Acquired with a Bosch handheld fundus camera:
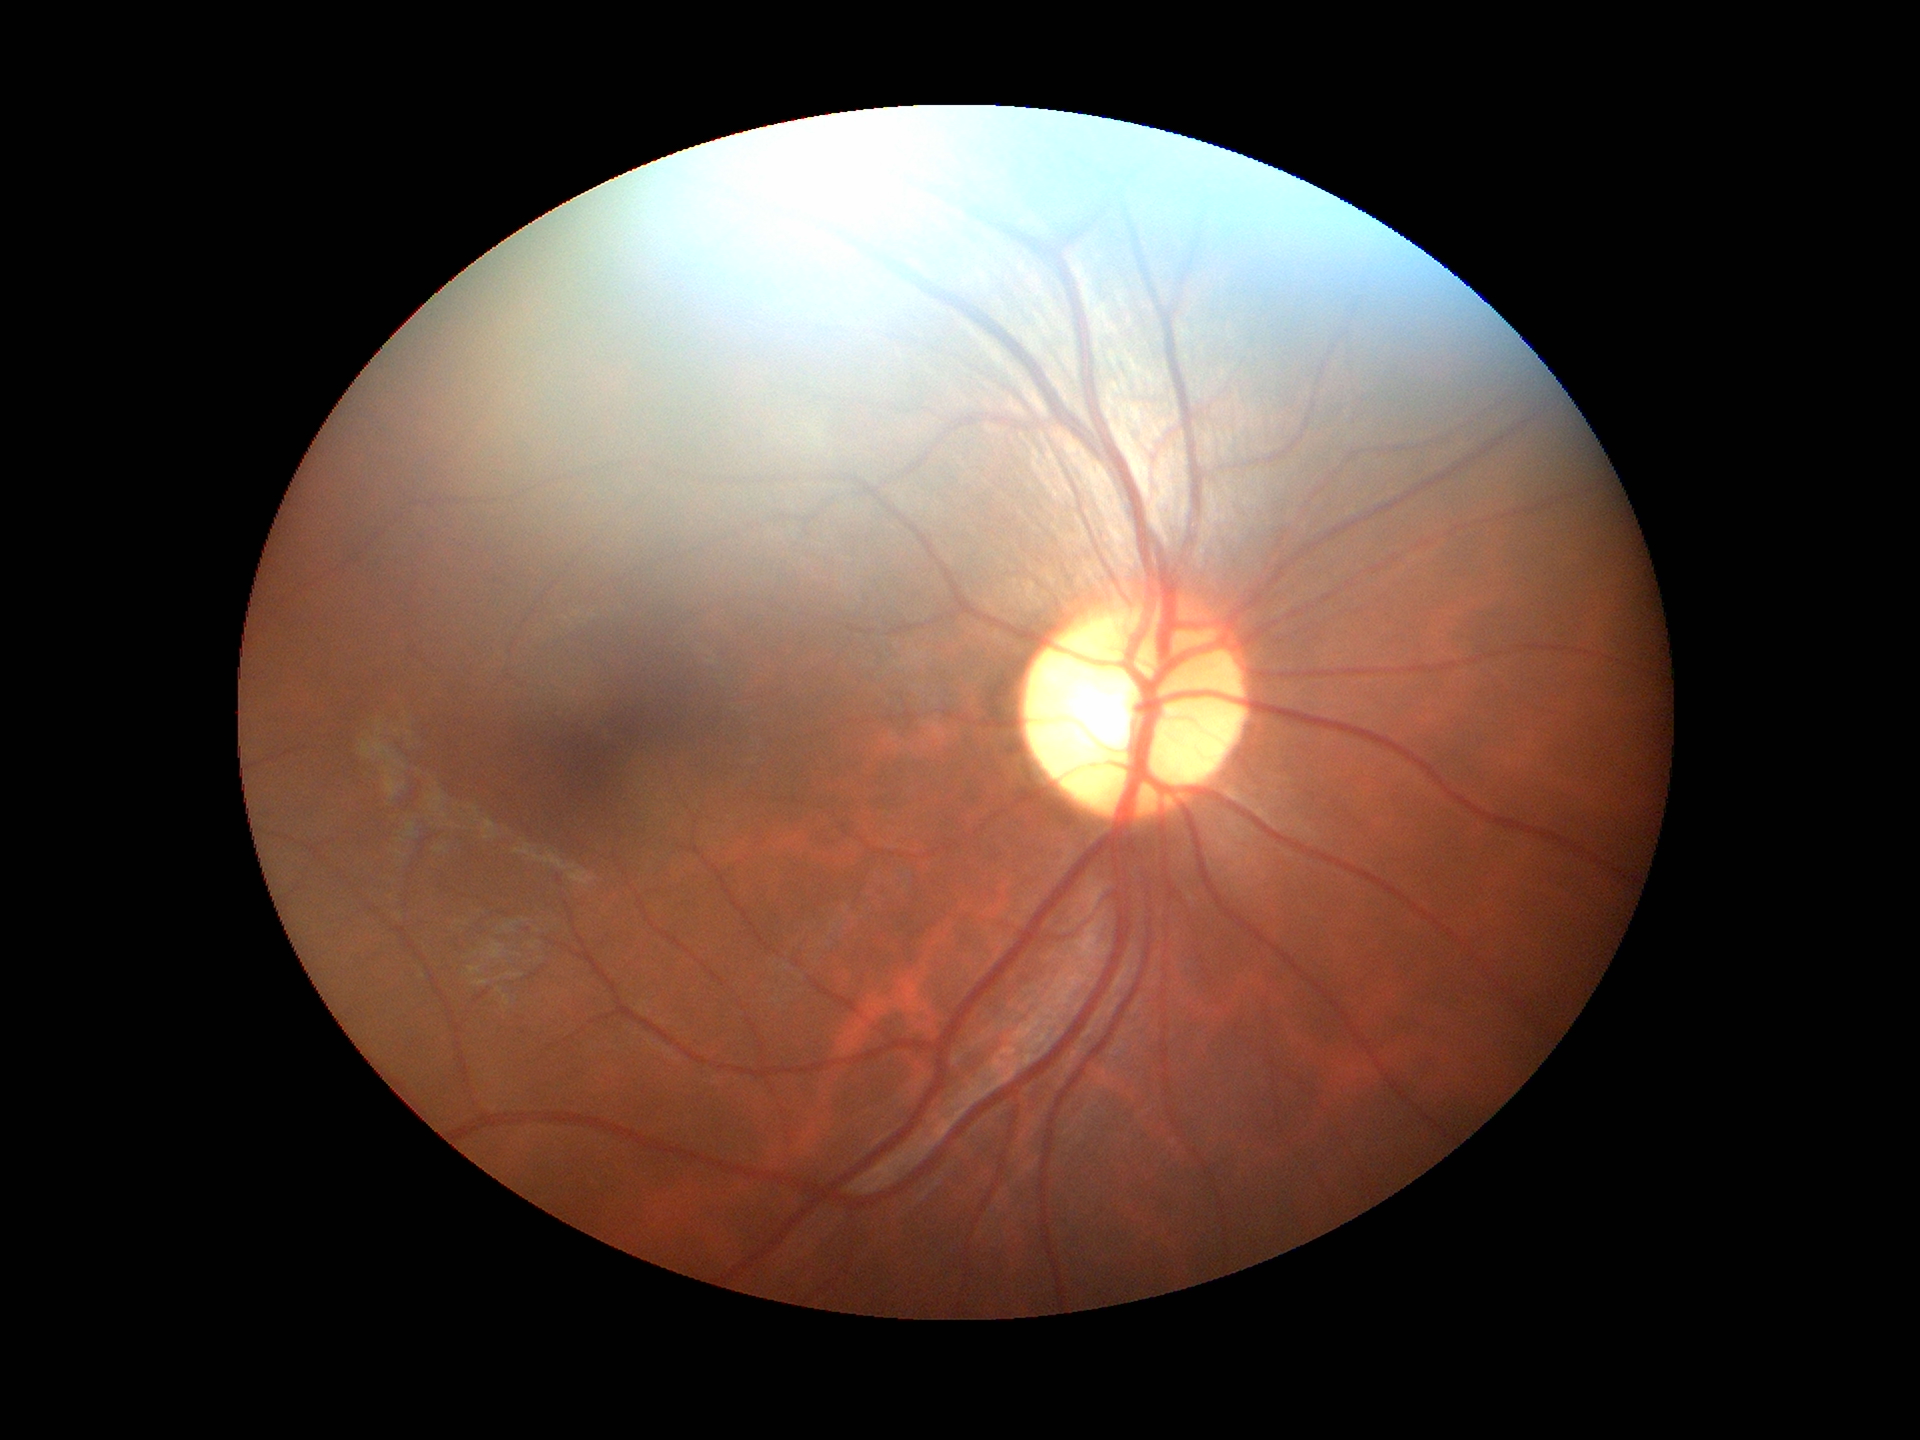 Glaucoma screening: no suspicious findings.
Vertical C/D ratio is 0.53.